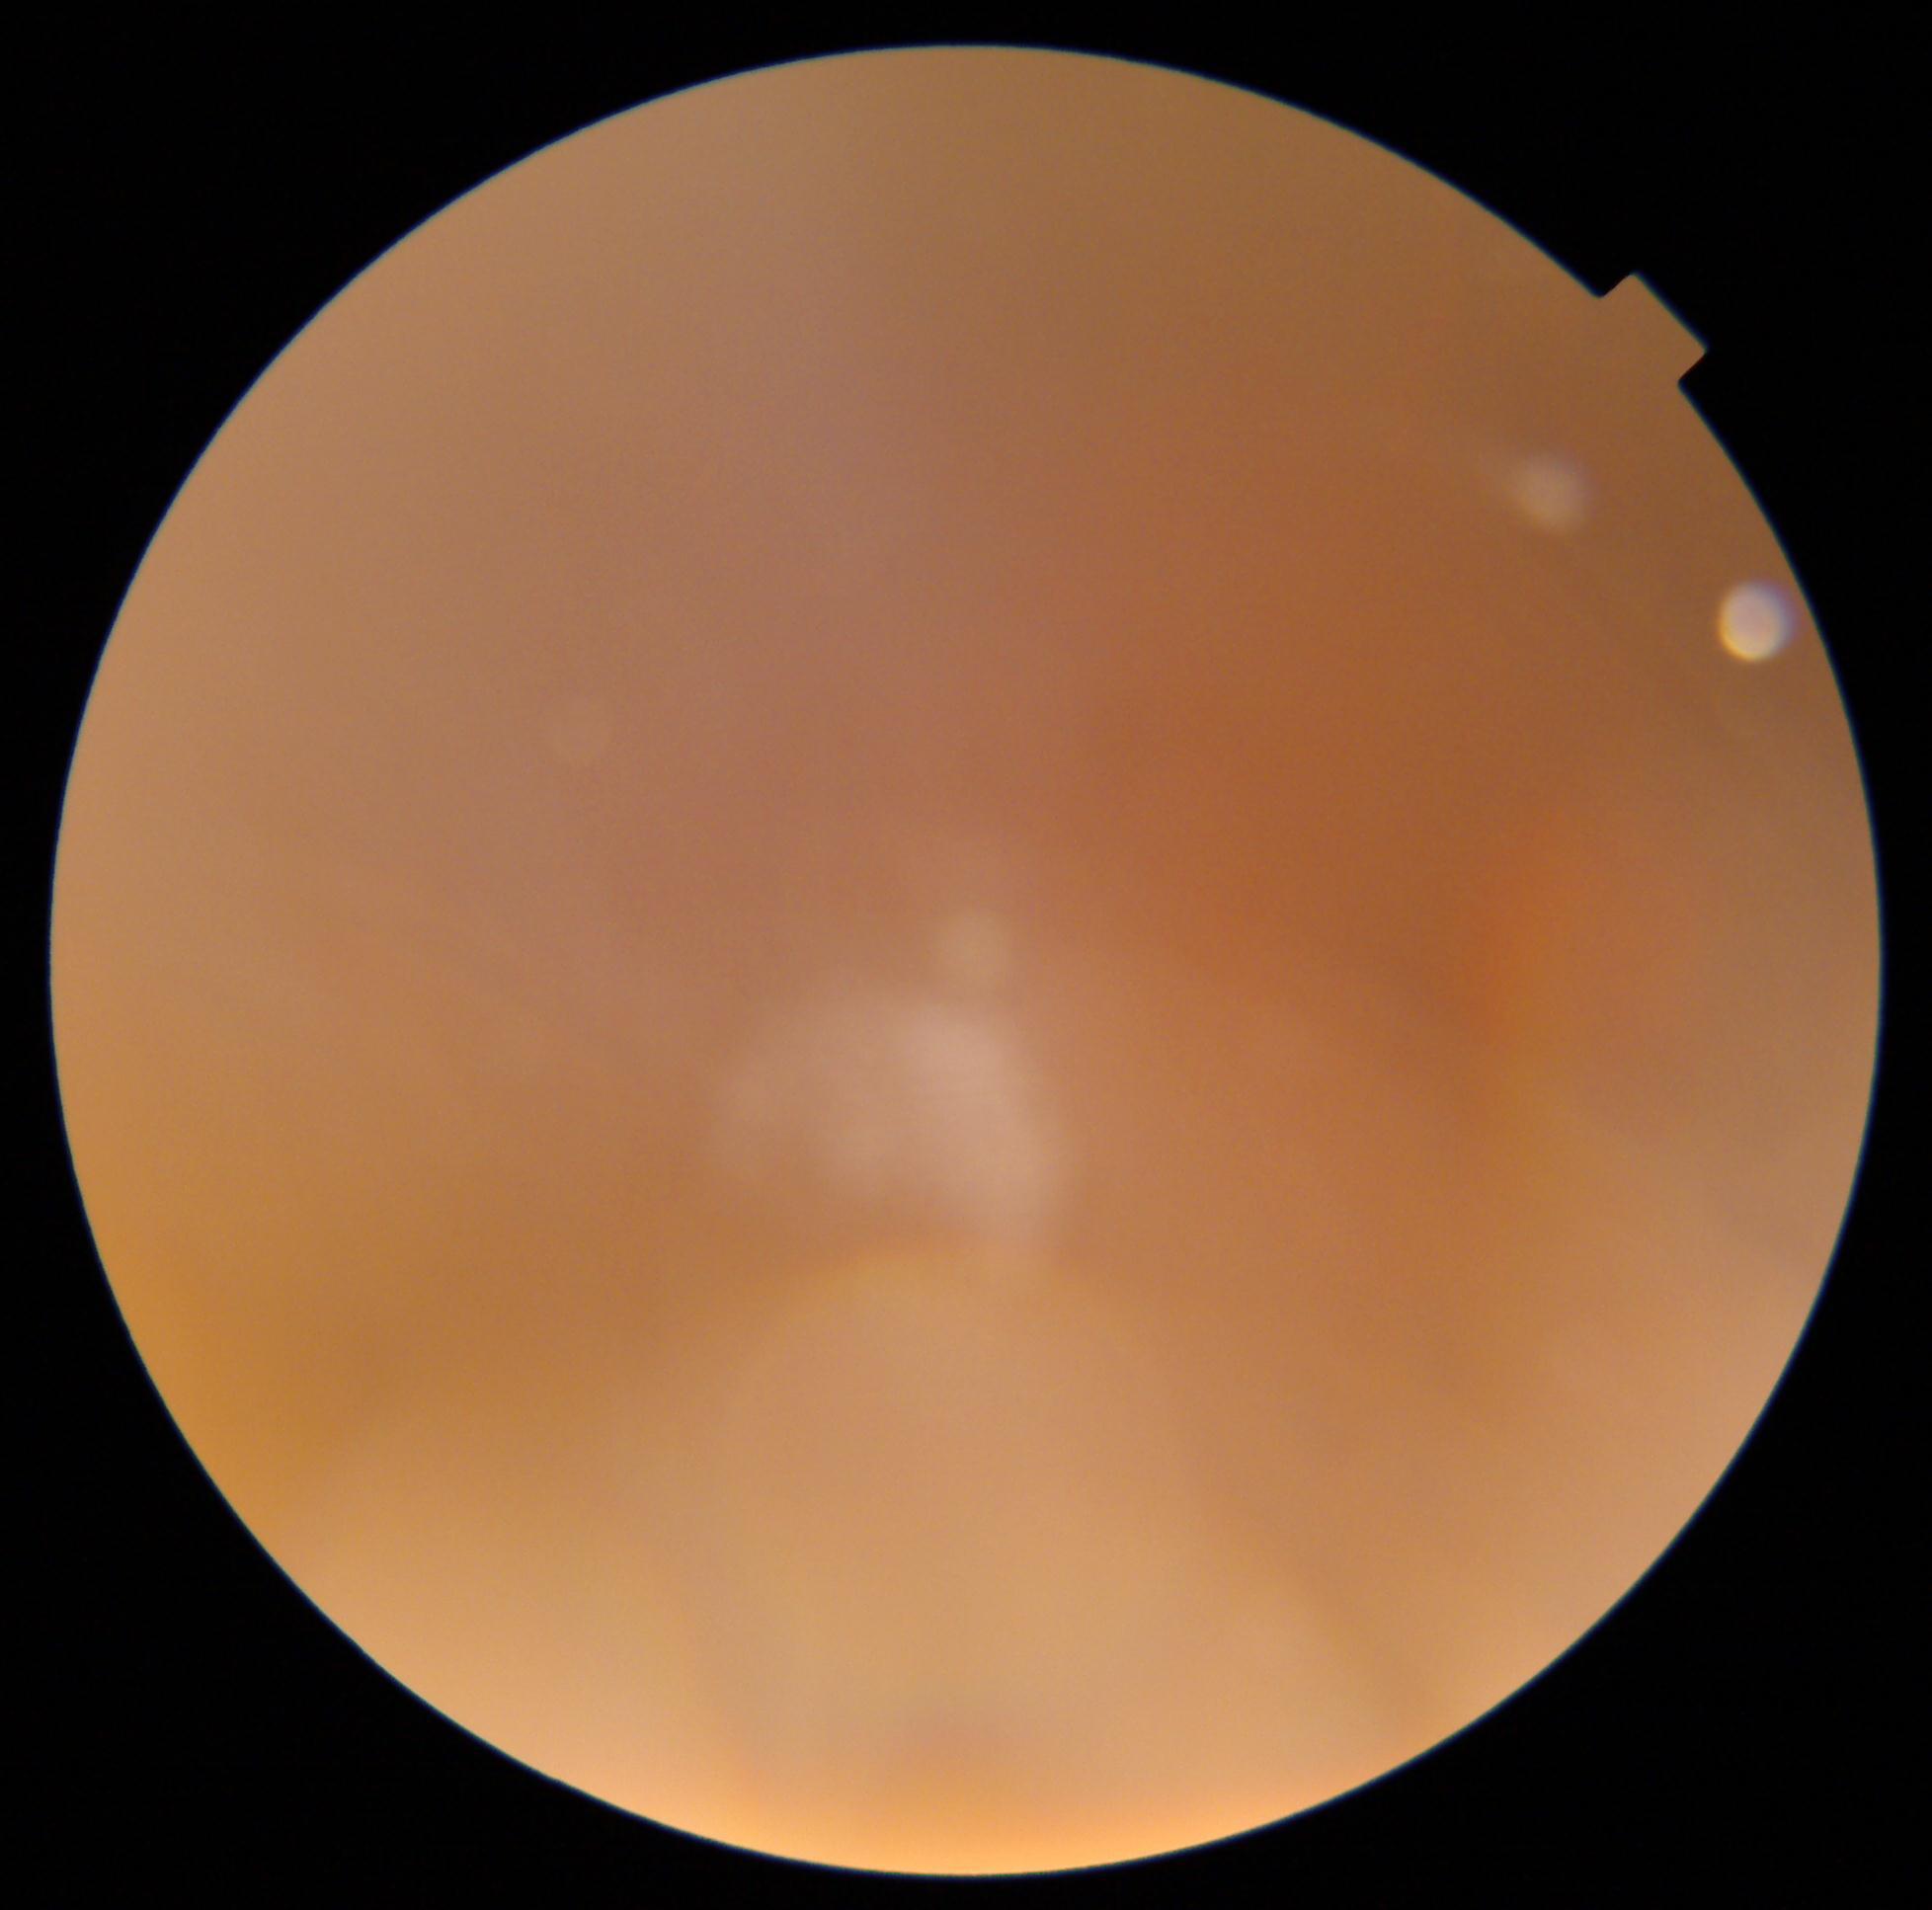
dr_grade: ungradable
quality: insufficient